Phoenix ICON wide-field infant fundus image: 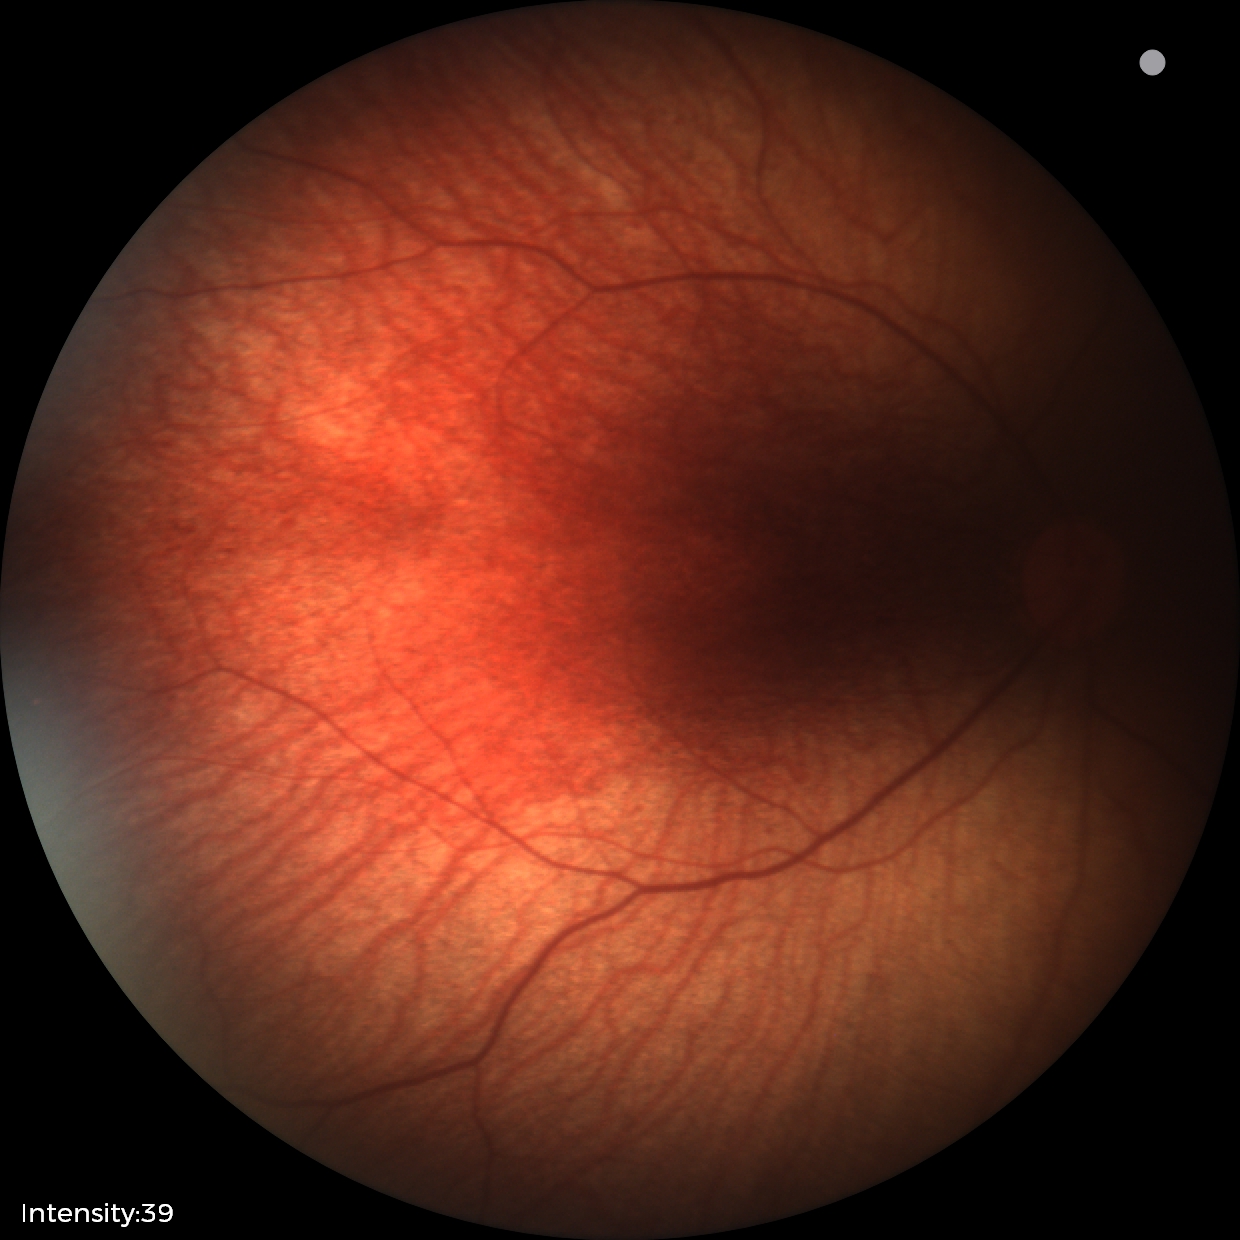 Screening examination diagnosed as physiological.